CFP, 848 by 848 pixels, 45° field of view, without pupil dilation, acquired with a NIDEK AFC-230:
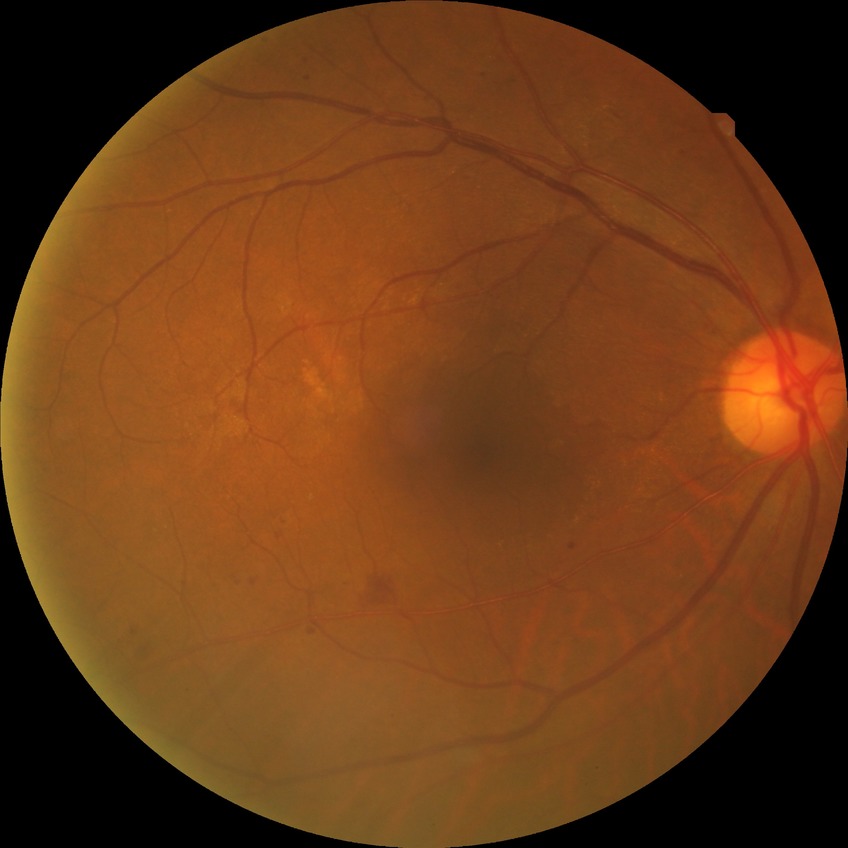
diabetic retinopathy (DR)=simple diabetic retinopathy (SDR).